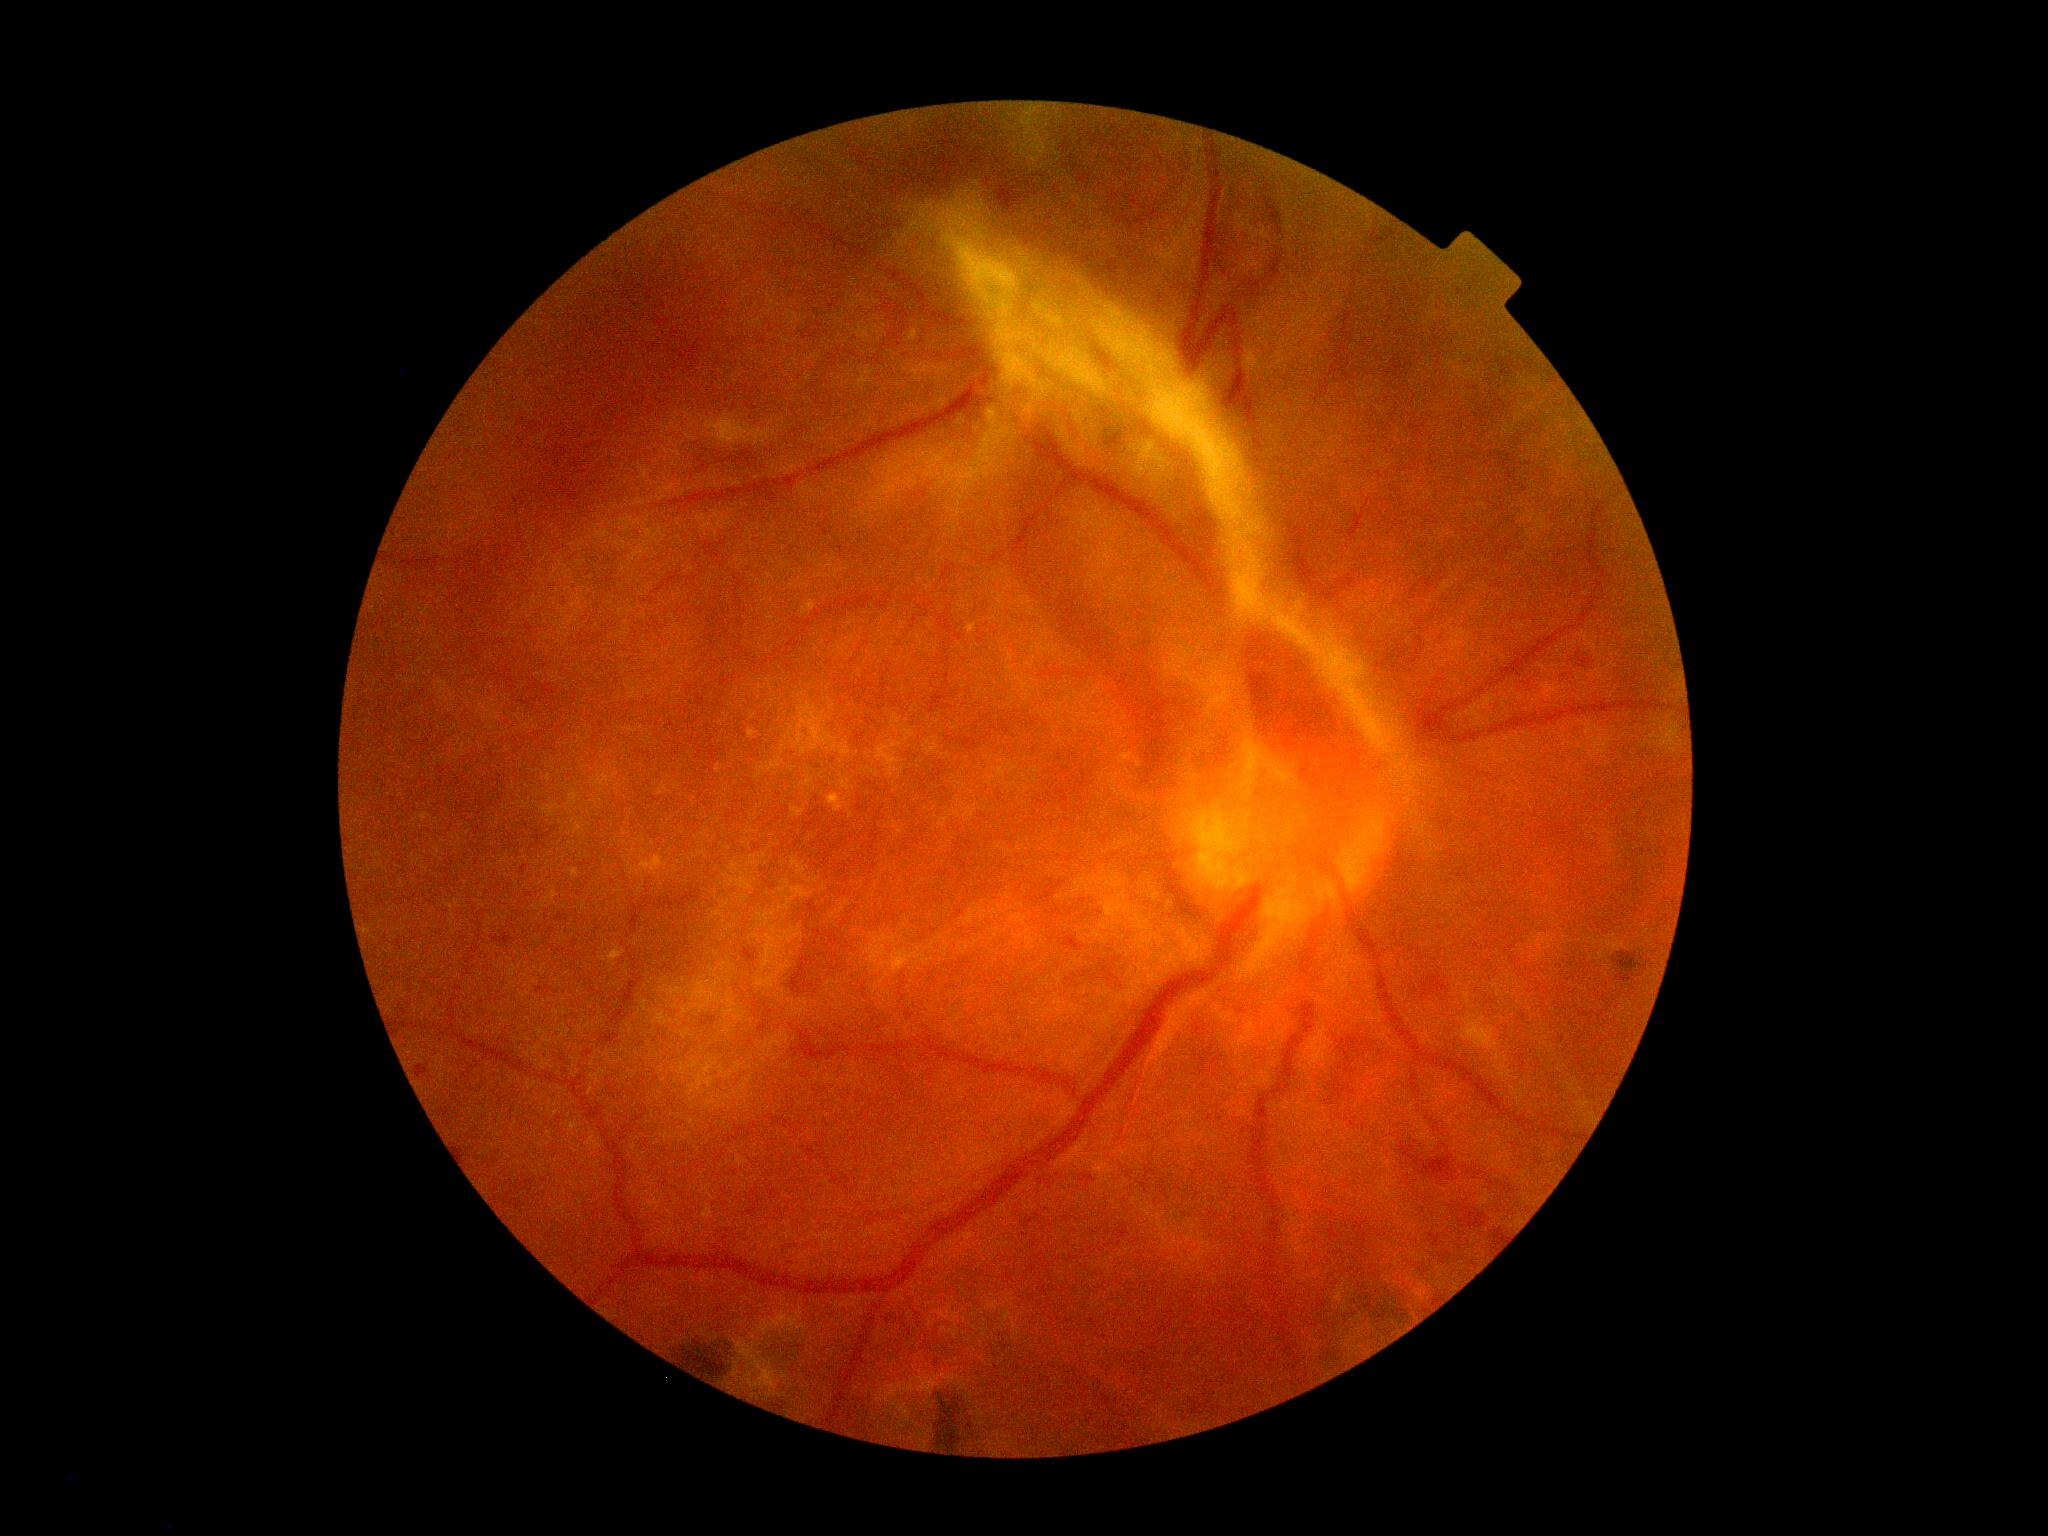

DR is grade 4. The retinopathy is classified as proliferative diabetic retinopathy.